FOV: 50 degrees — 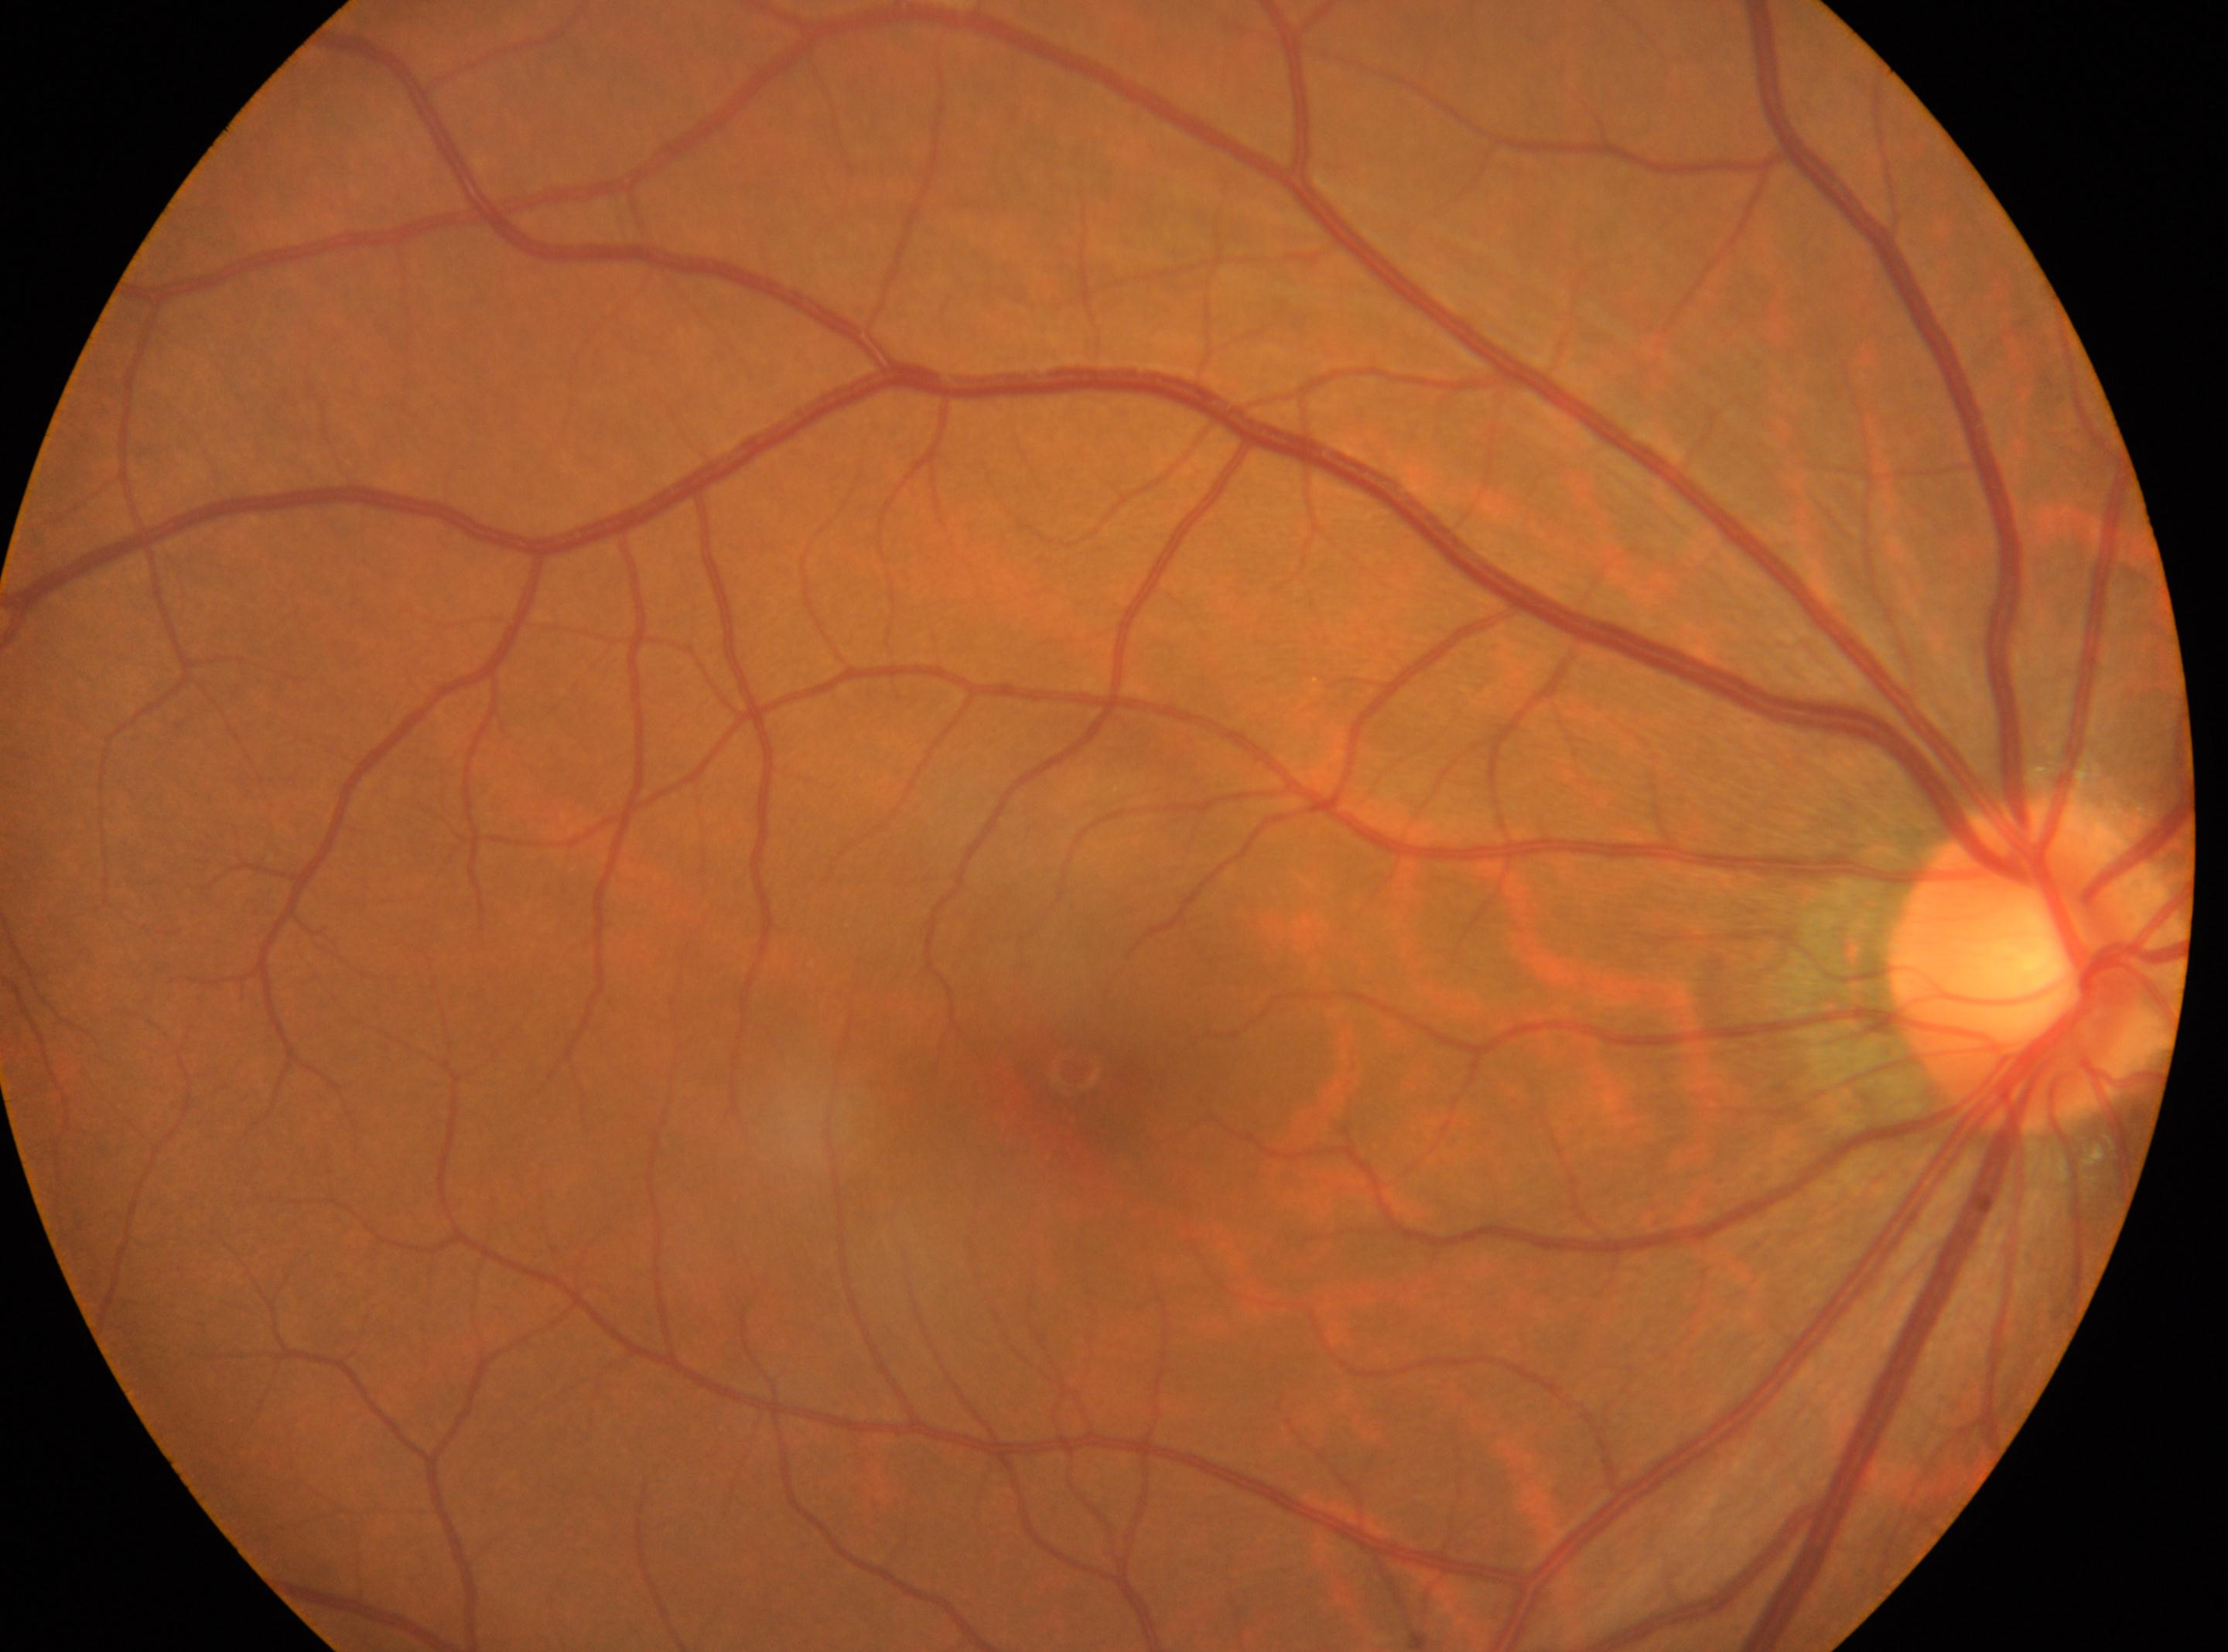
{"eye": "OD", "fovea": "[1080, 1084]", "optic_disc": "[2038, 959]", "dr_grade": "0 (no apparent retinopathy) — no visible signs of diabetic retinopathy"}